1380x1382; 45° field of view.
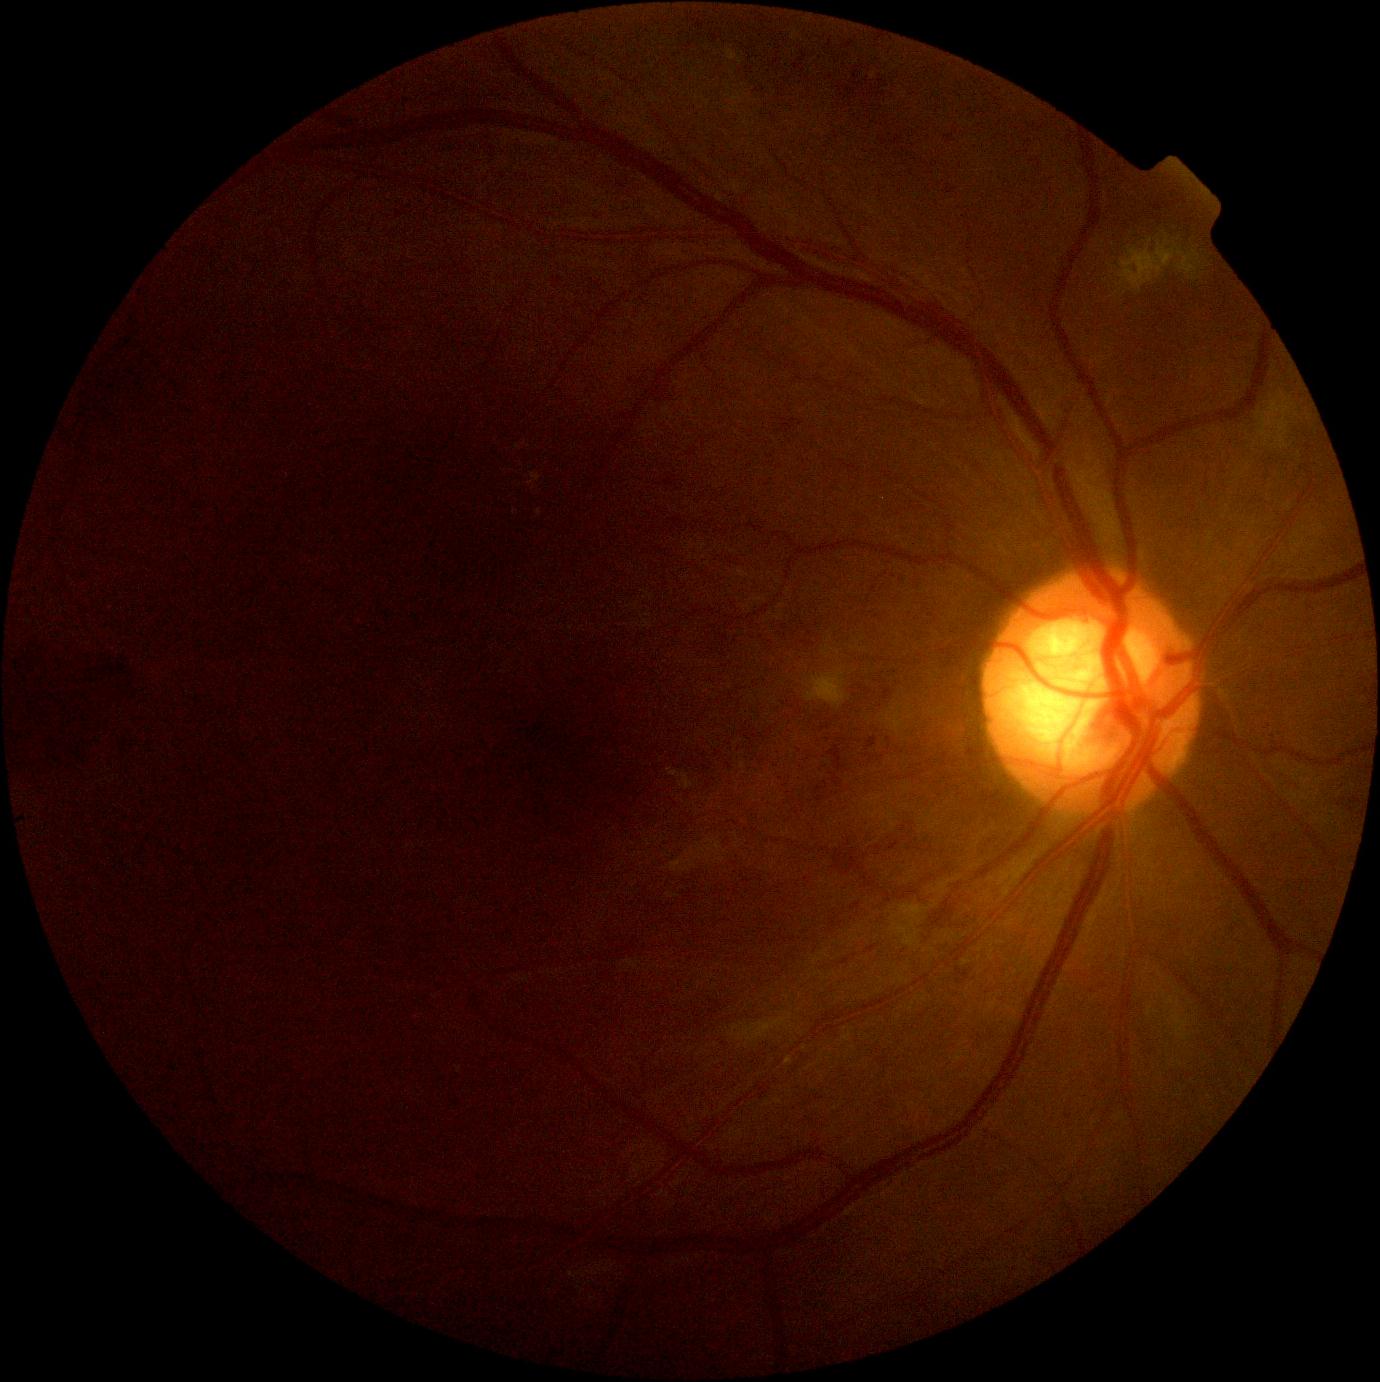 Diabetic retinopathy severity is 2.